Wide-field contact fundus photograph of an infant; Phoenix ICON, 100° FOV.
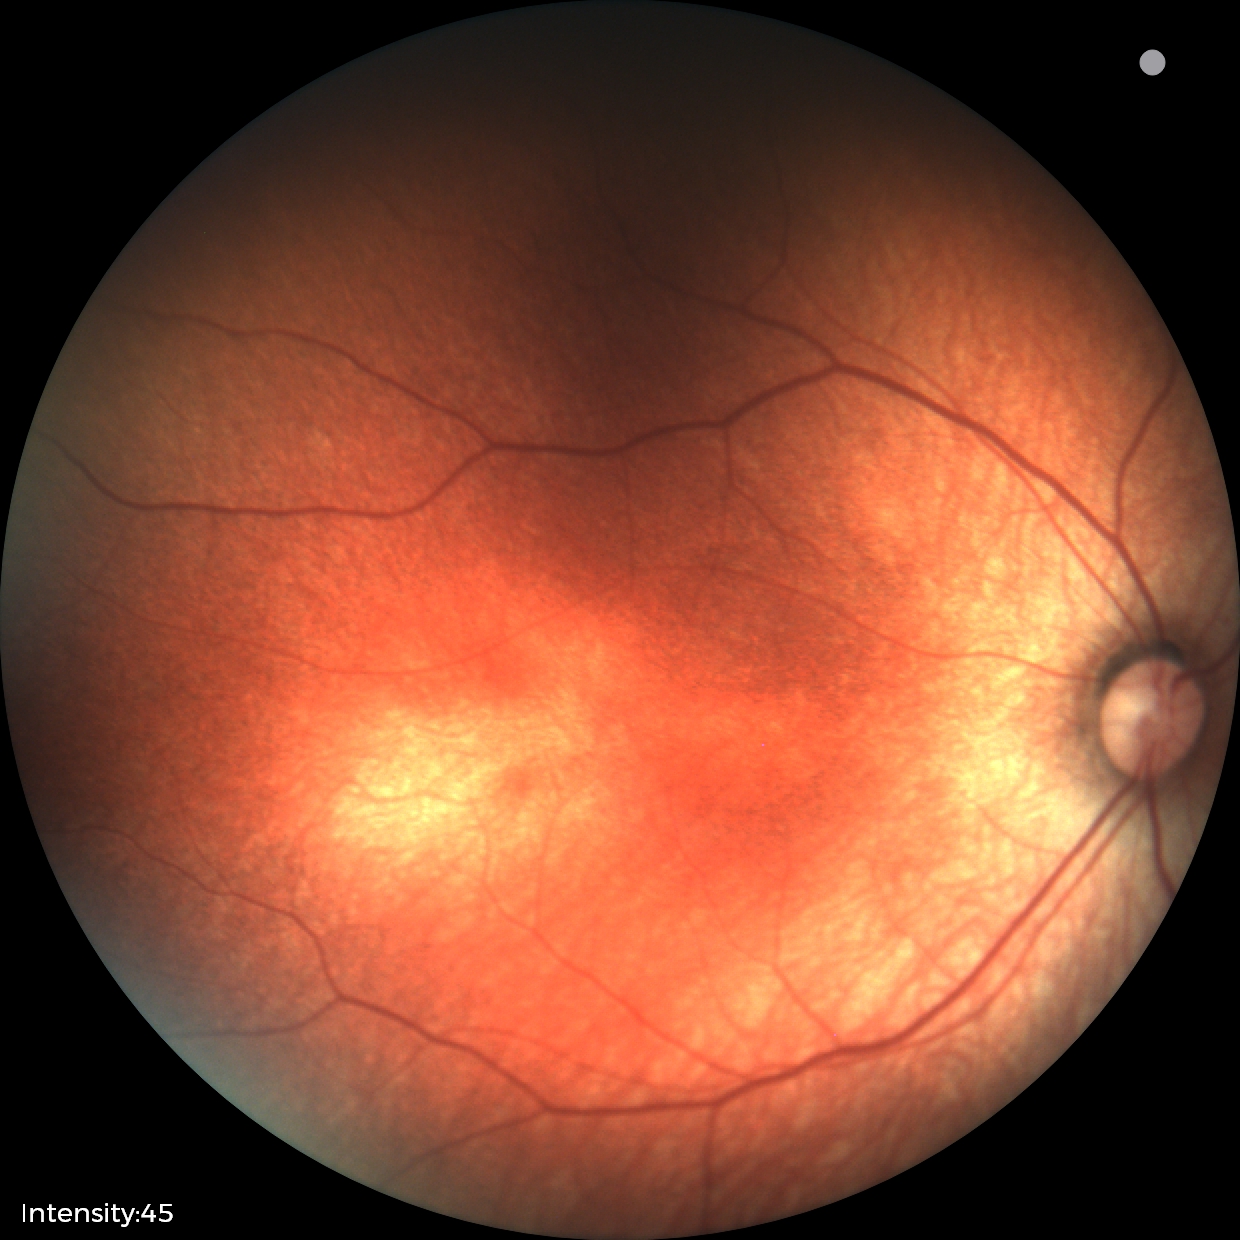

Physiological retinal appearance for postconceptual age.